45° FOV, modified Davis classification — 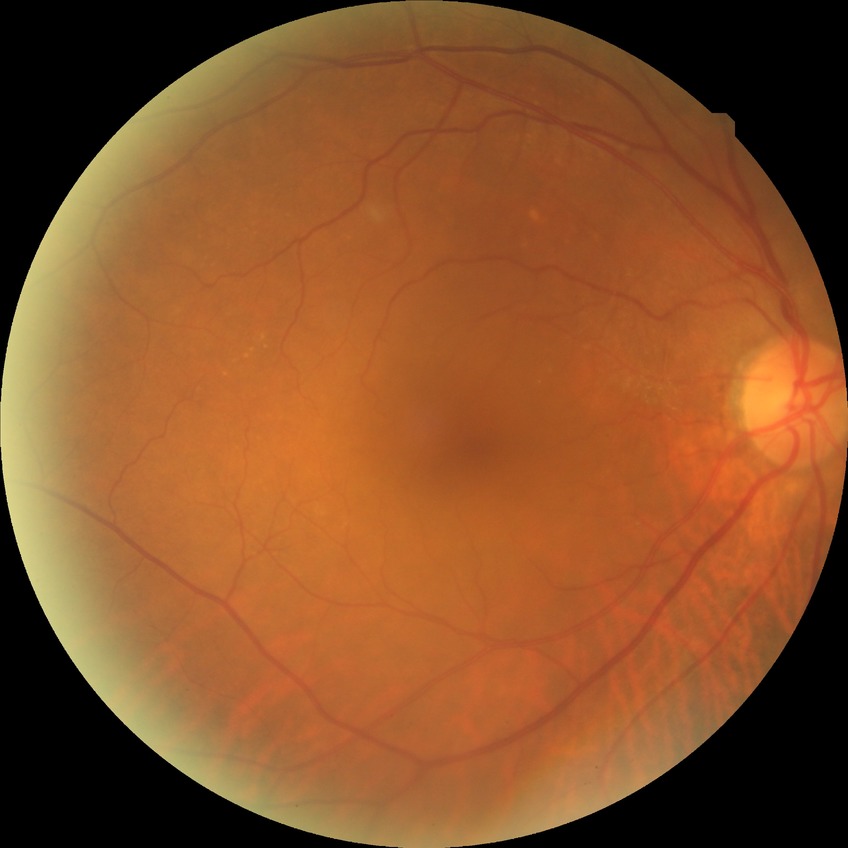
Diabetic retinopathy (DR) is simple diabetic retinopathy (SDR).